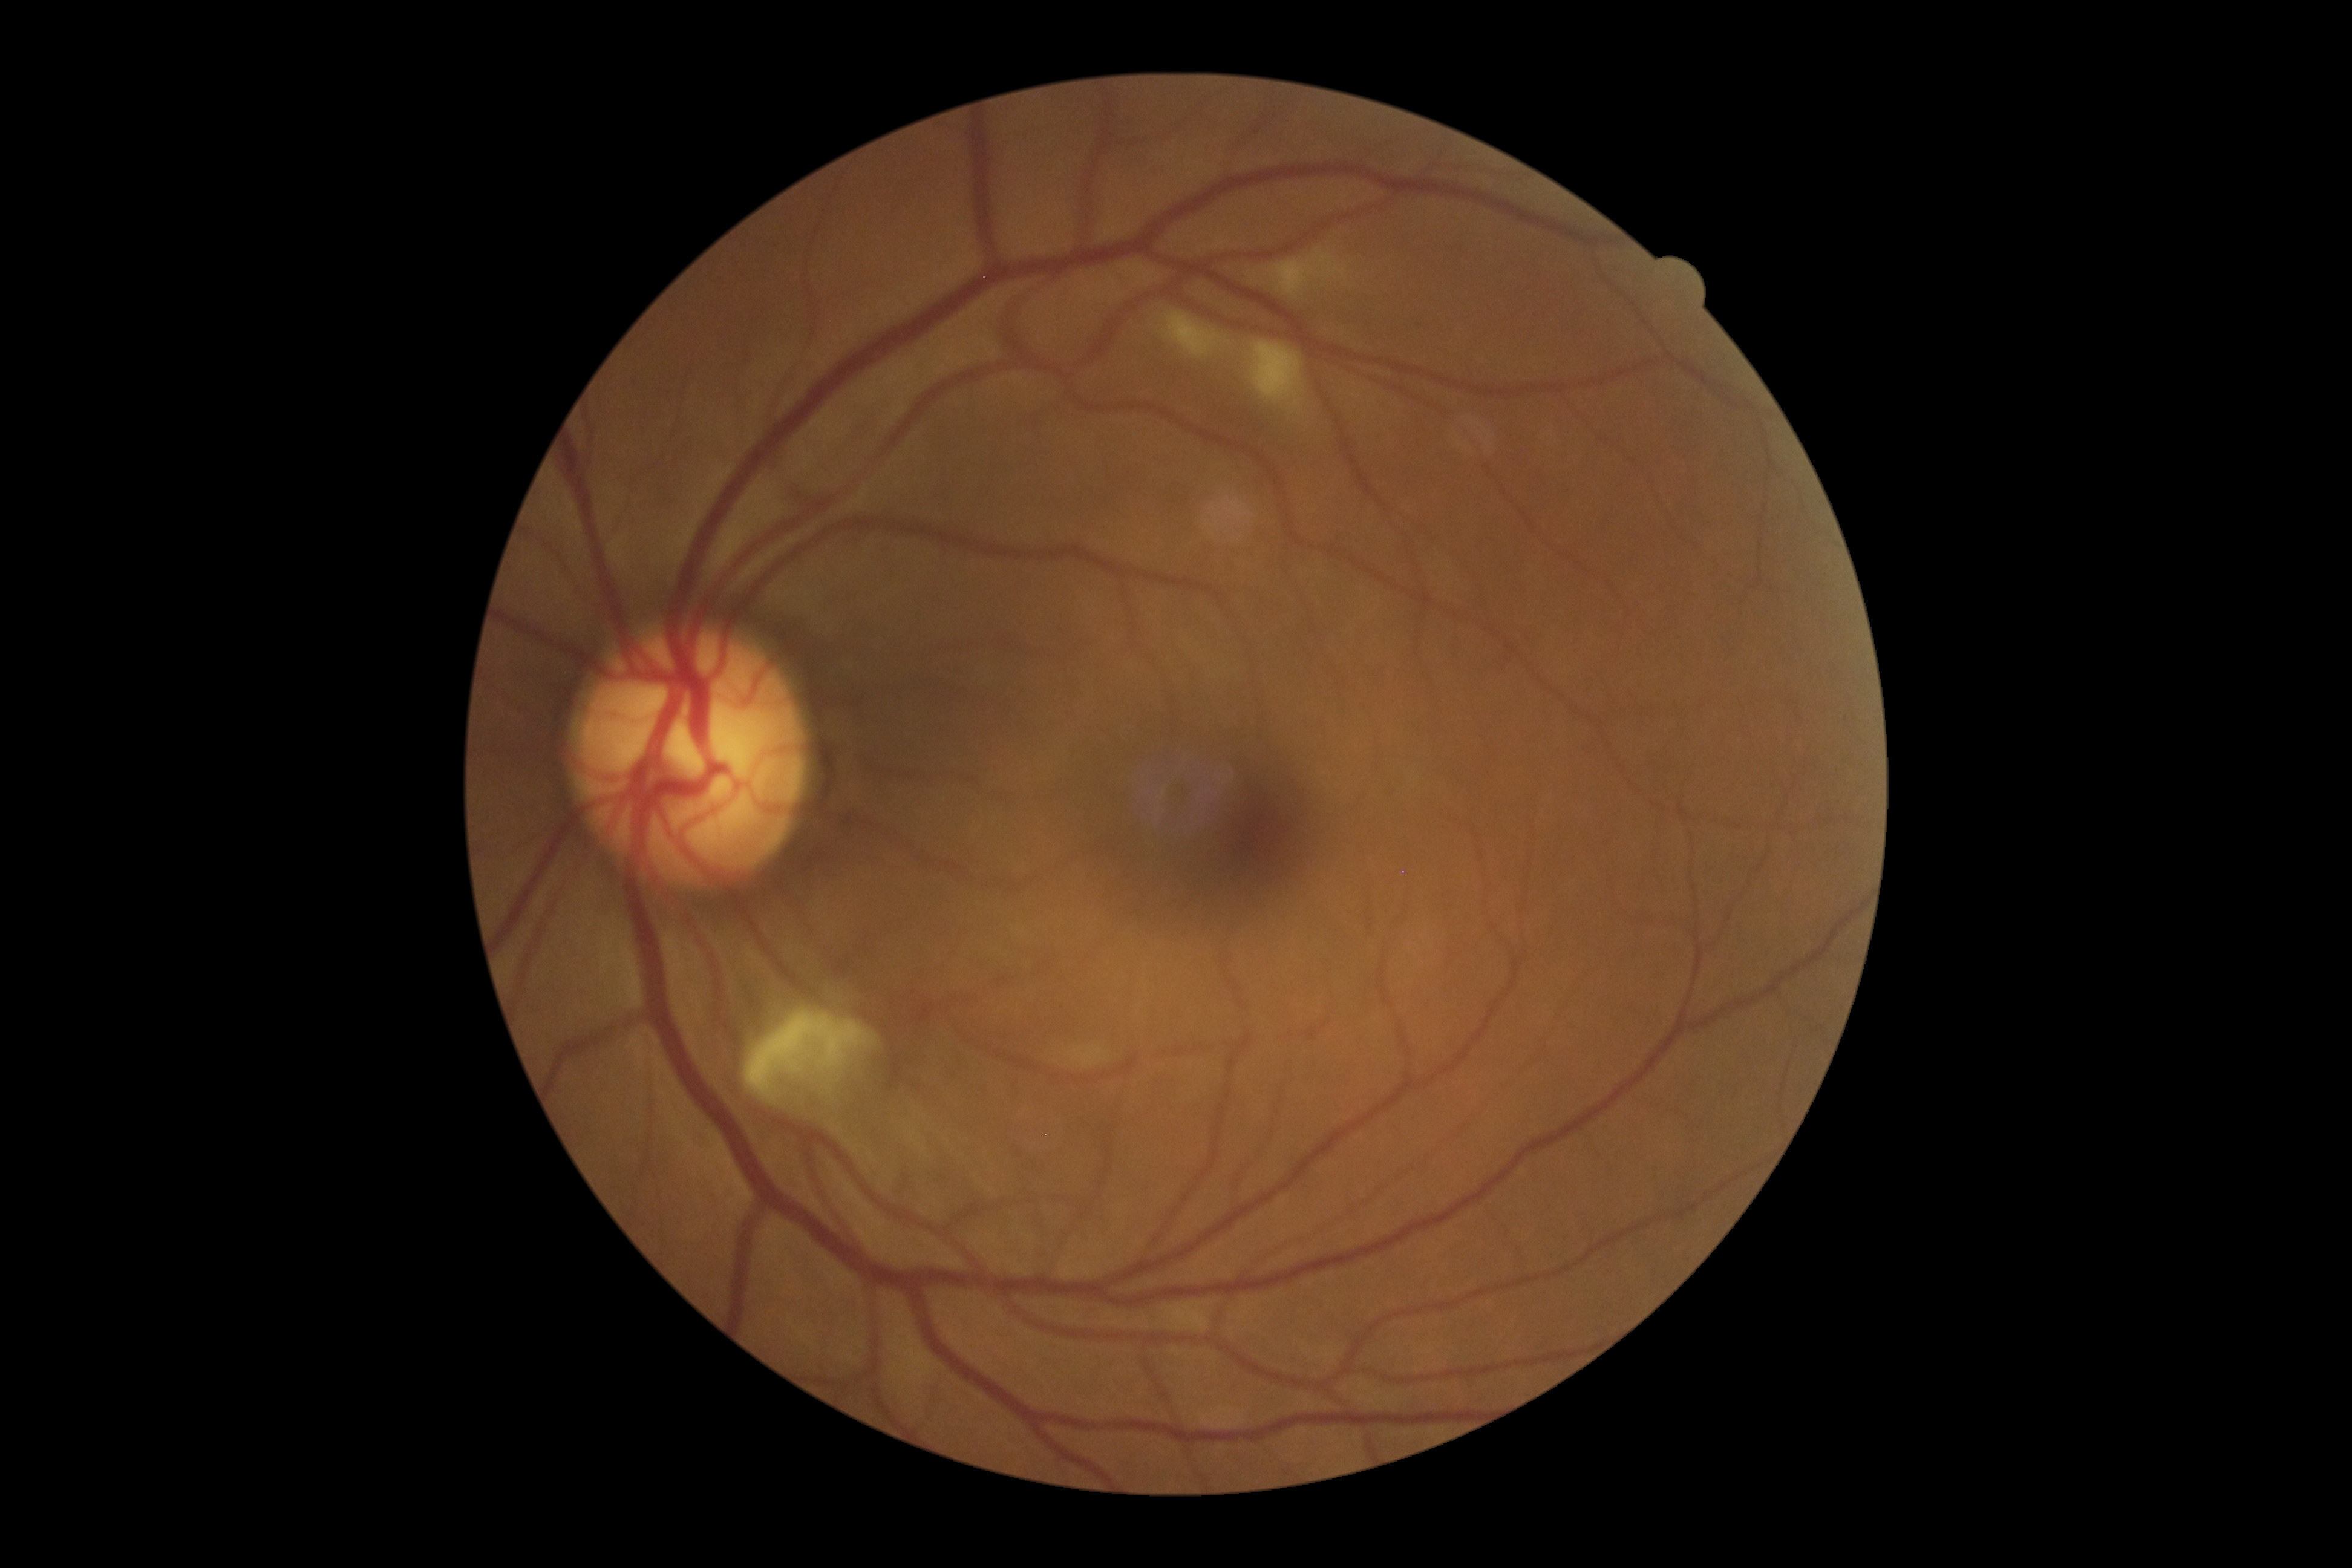
Retinopathy grade: 2 (moderate NPDR).